Wide-field fundus photograph from neonatal ROP screening — 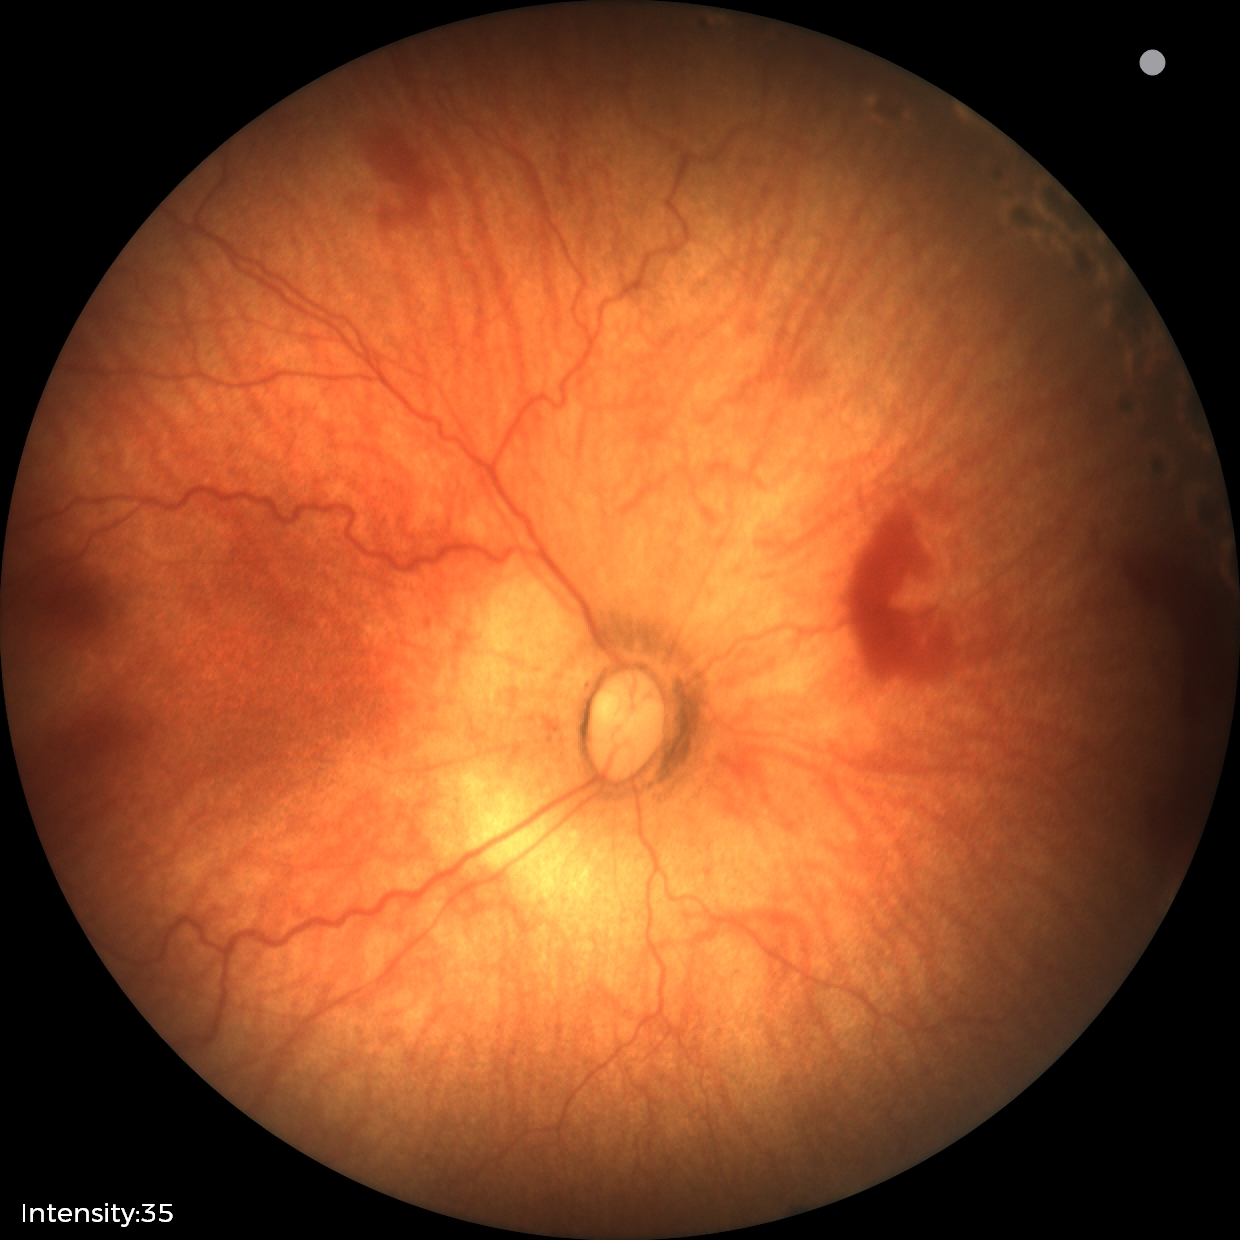
Impression = status post ROP
plus disease = absent — posterior pole vessels without abnormal dilation or tortuosity